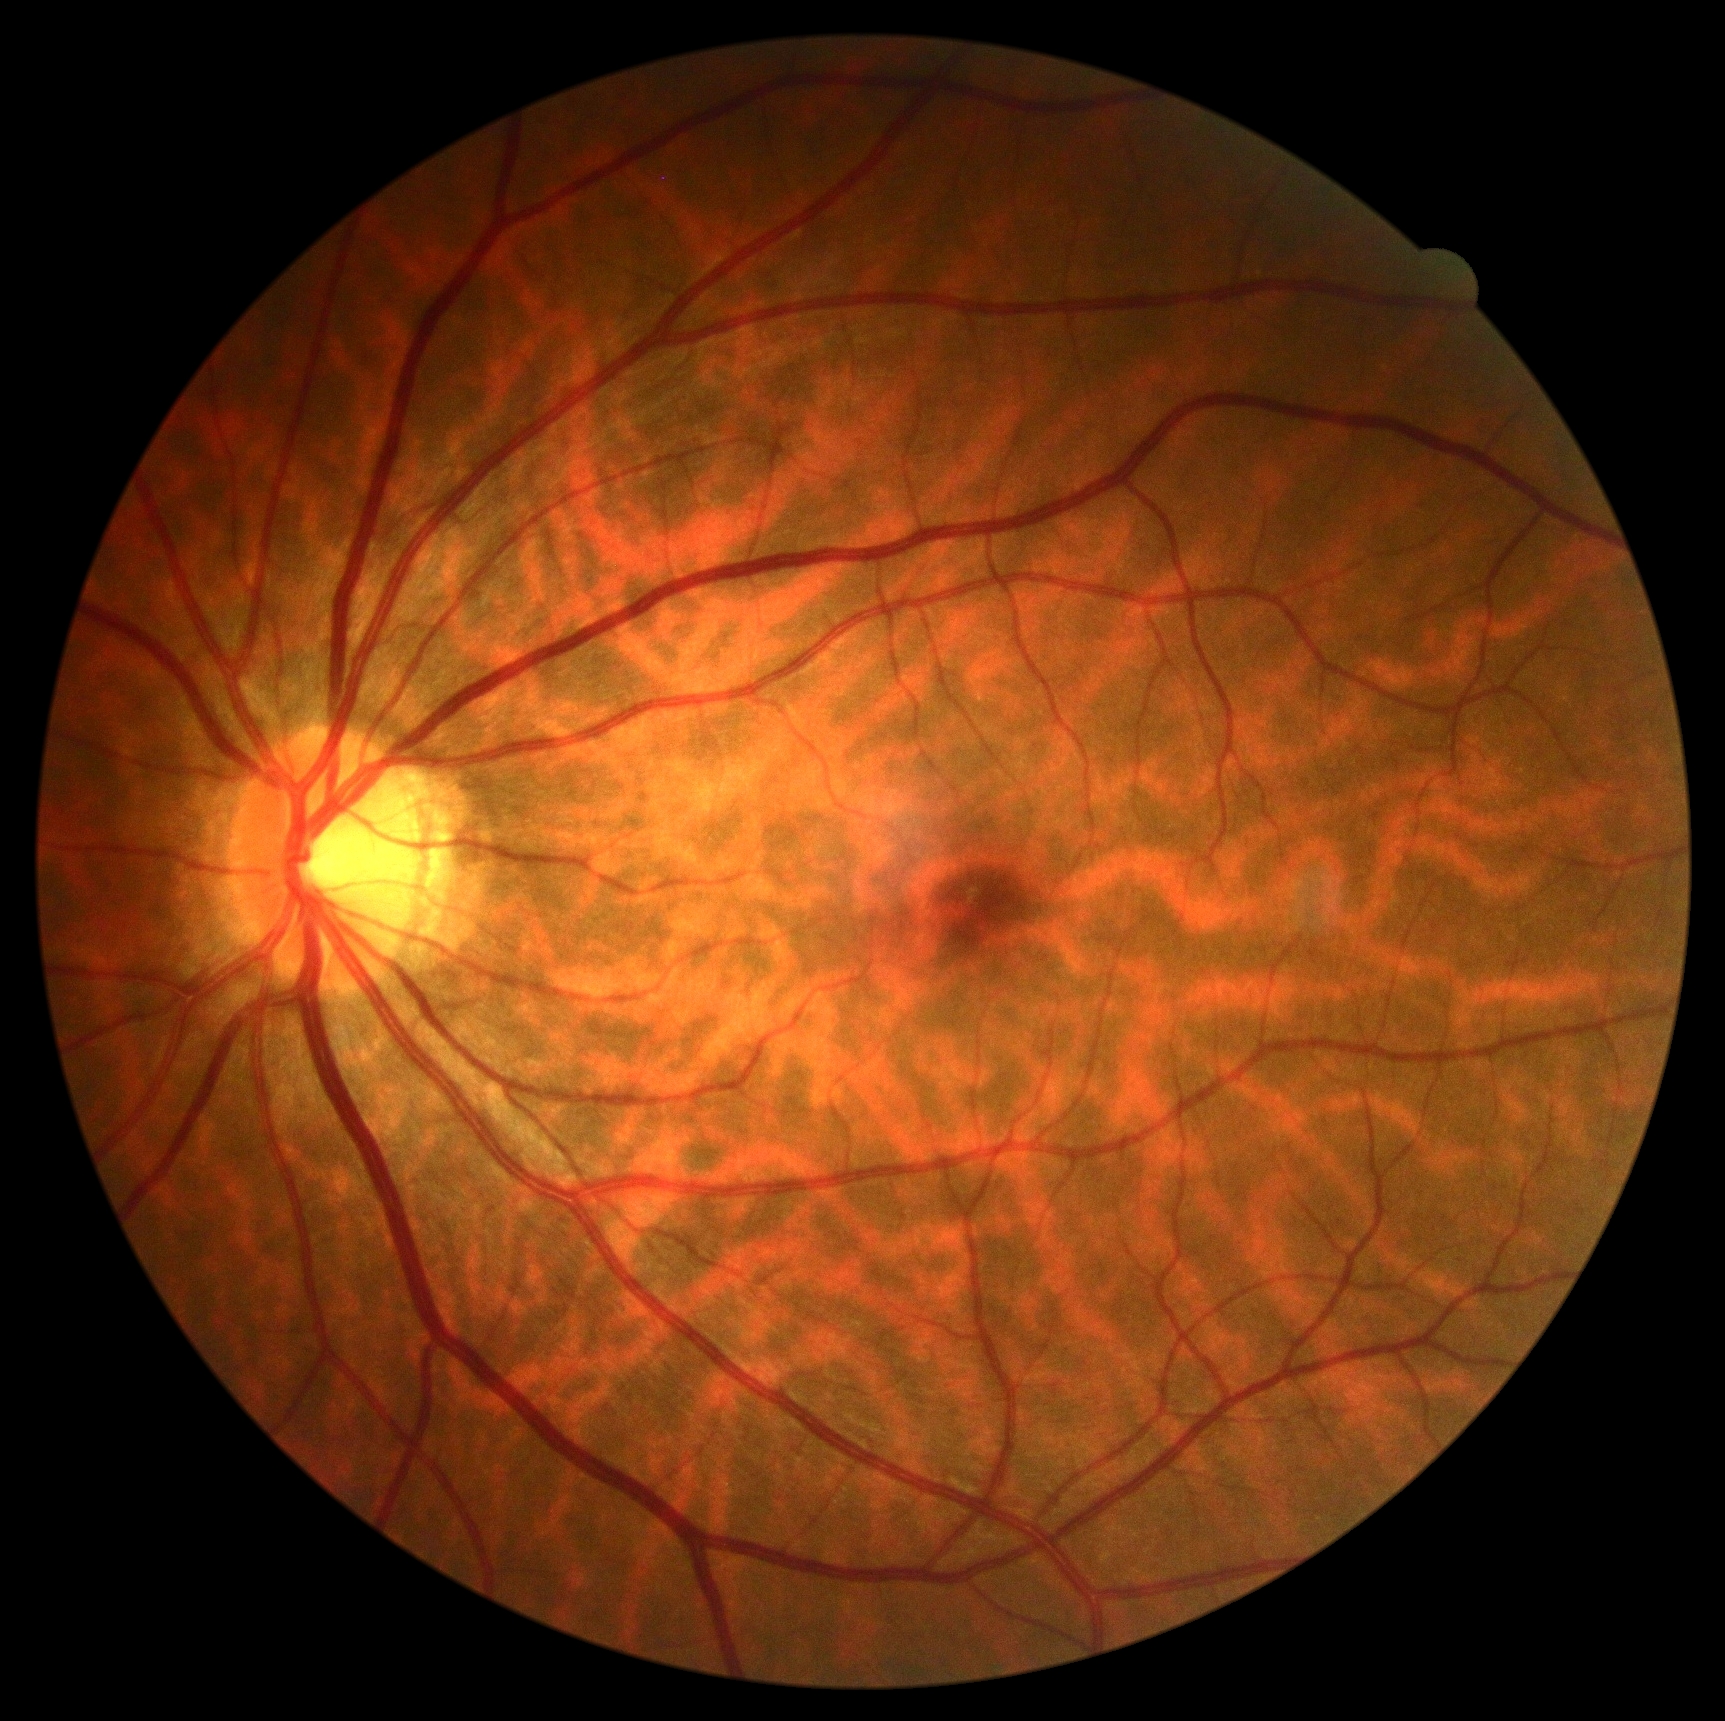

diabetic retinopathy (DR) = 0